Graded on the modified Davis scale.
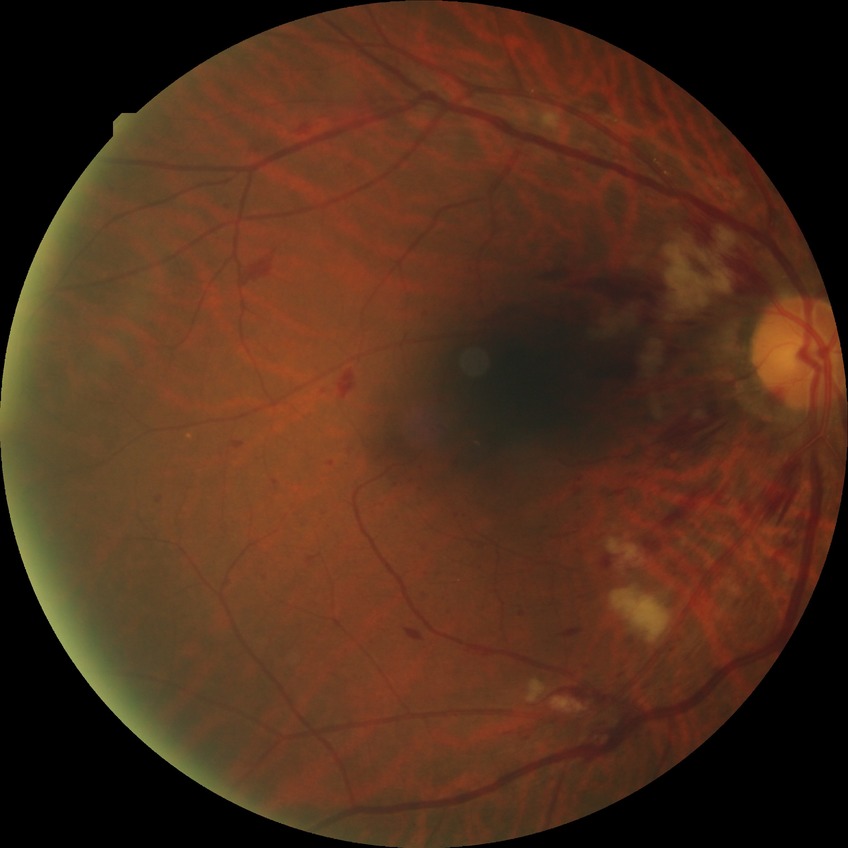
davis_grade: PPDR